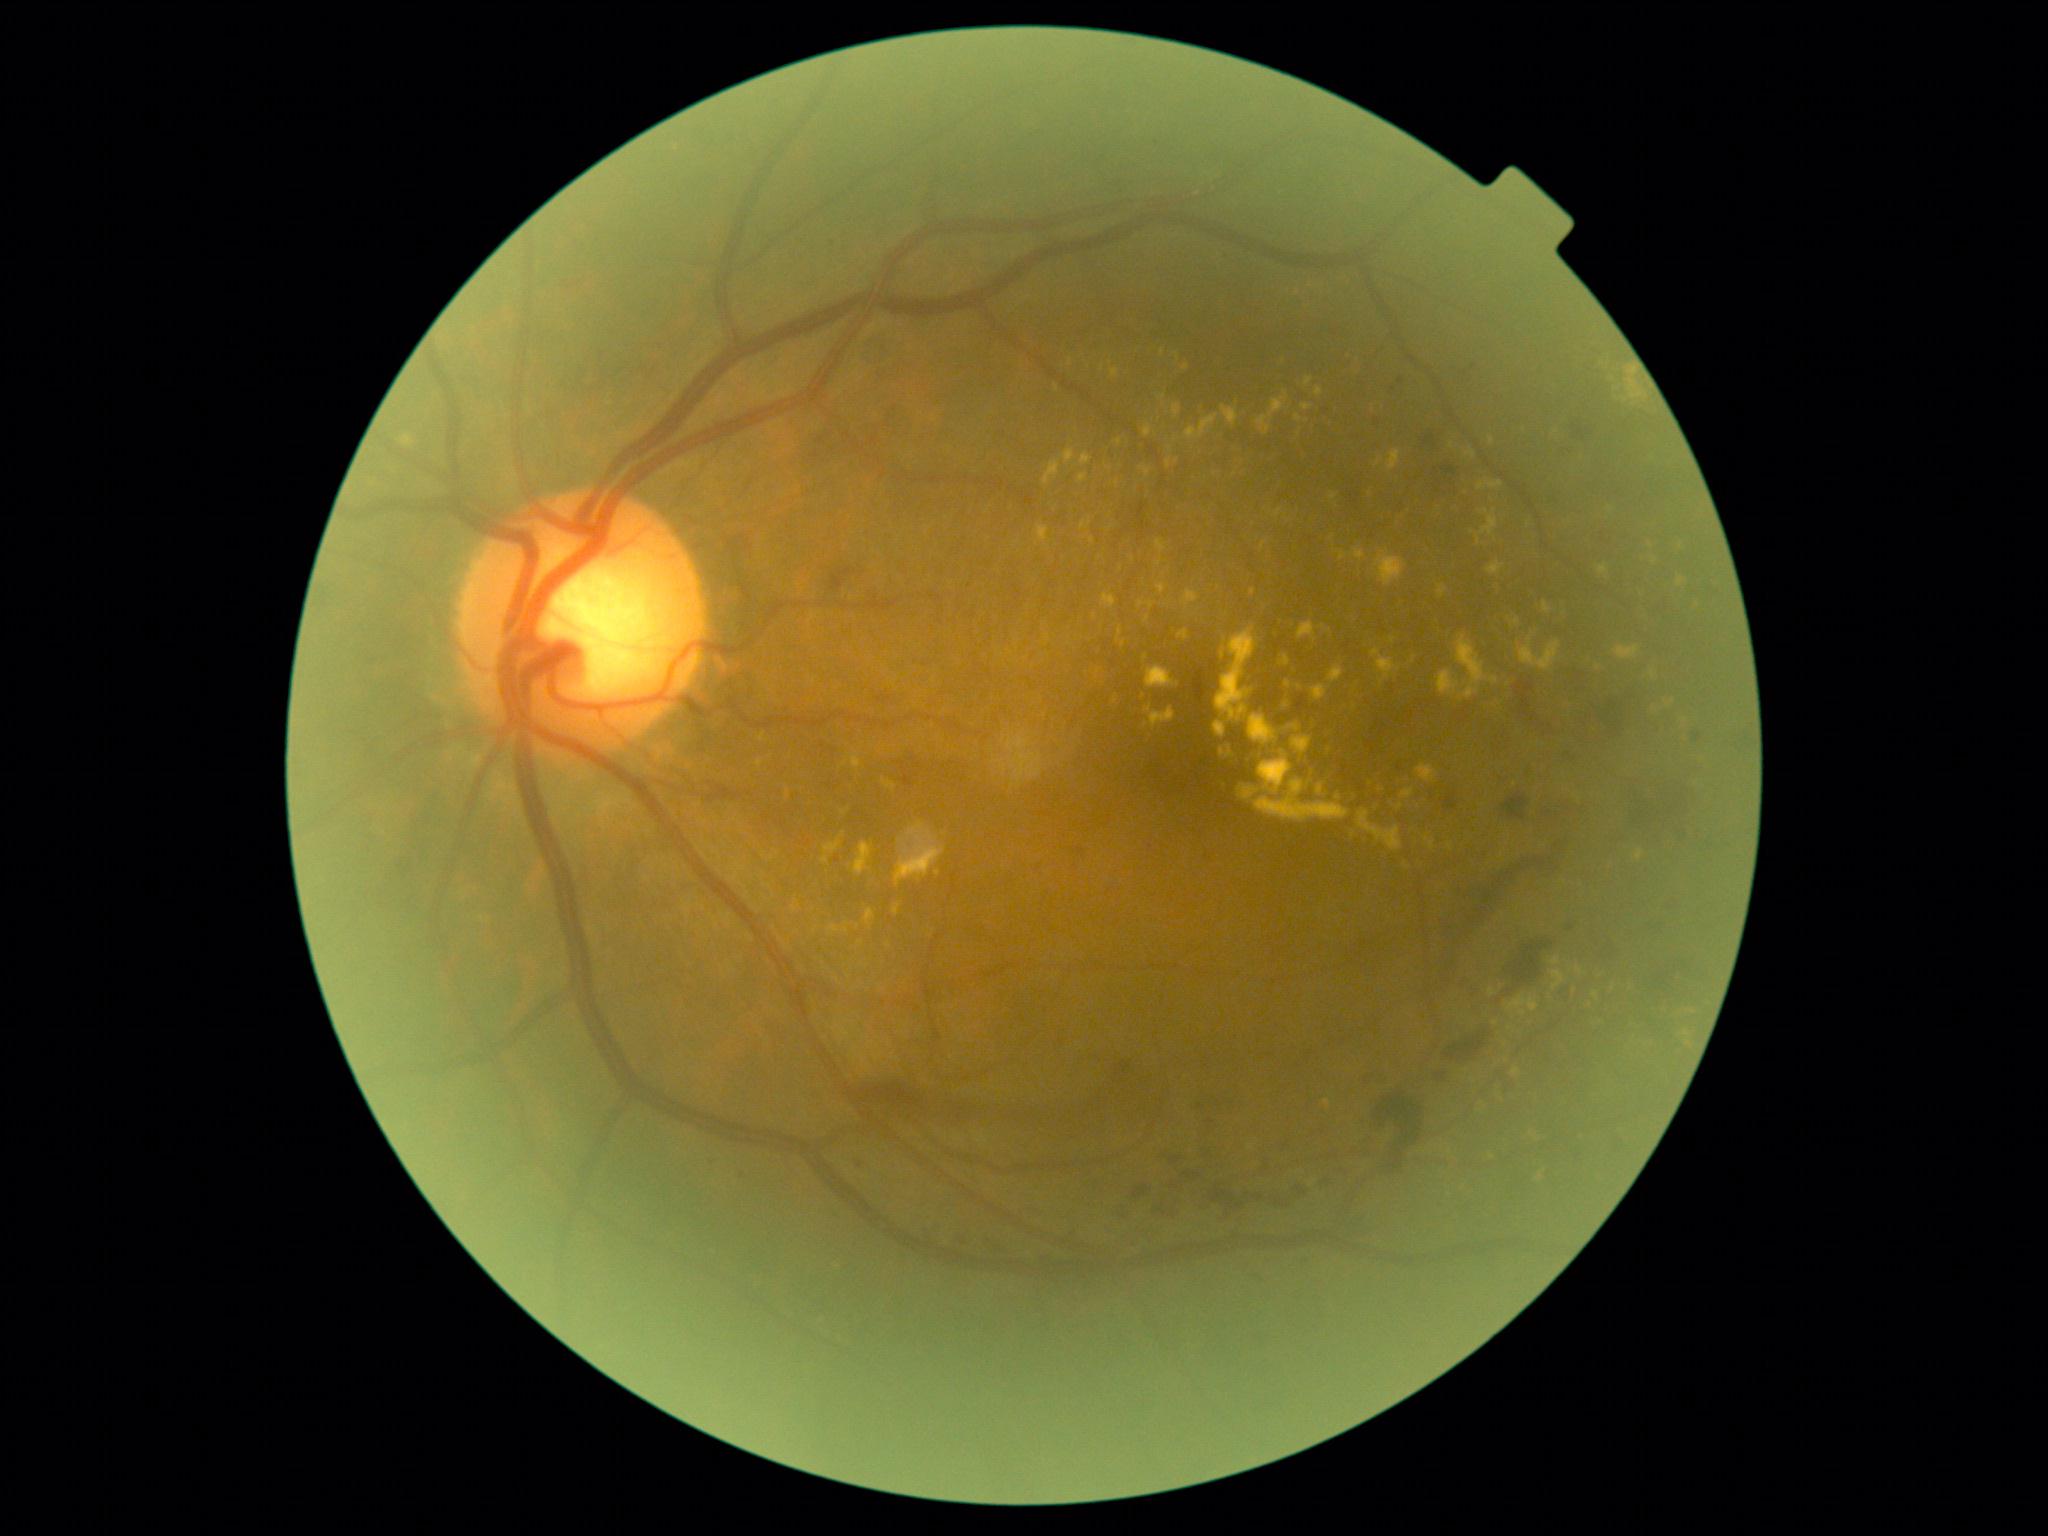
DR stage: 2/4. EXs are present, including at 788:790:791:798; 1614:646:1640:660; 828:926:841:933; 1324:1099:1332:1108; 1280:656:1290:668; 1357:809:1403:851; 1081:522:1087:530; 893:904:900:916; 1081:453:1092:467; 1312:685:1328:701; 1511:780:1520:787; 1477:510:1498:545. Additional small EXs near 1523/1014; 1450/847; 1339/797; 1235/475; 1134/560; 1528/525; 1382/681.